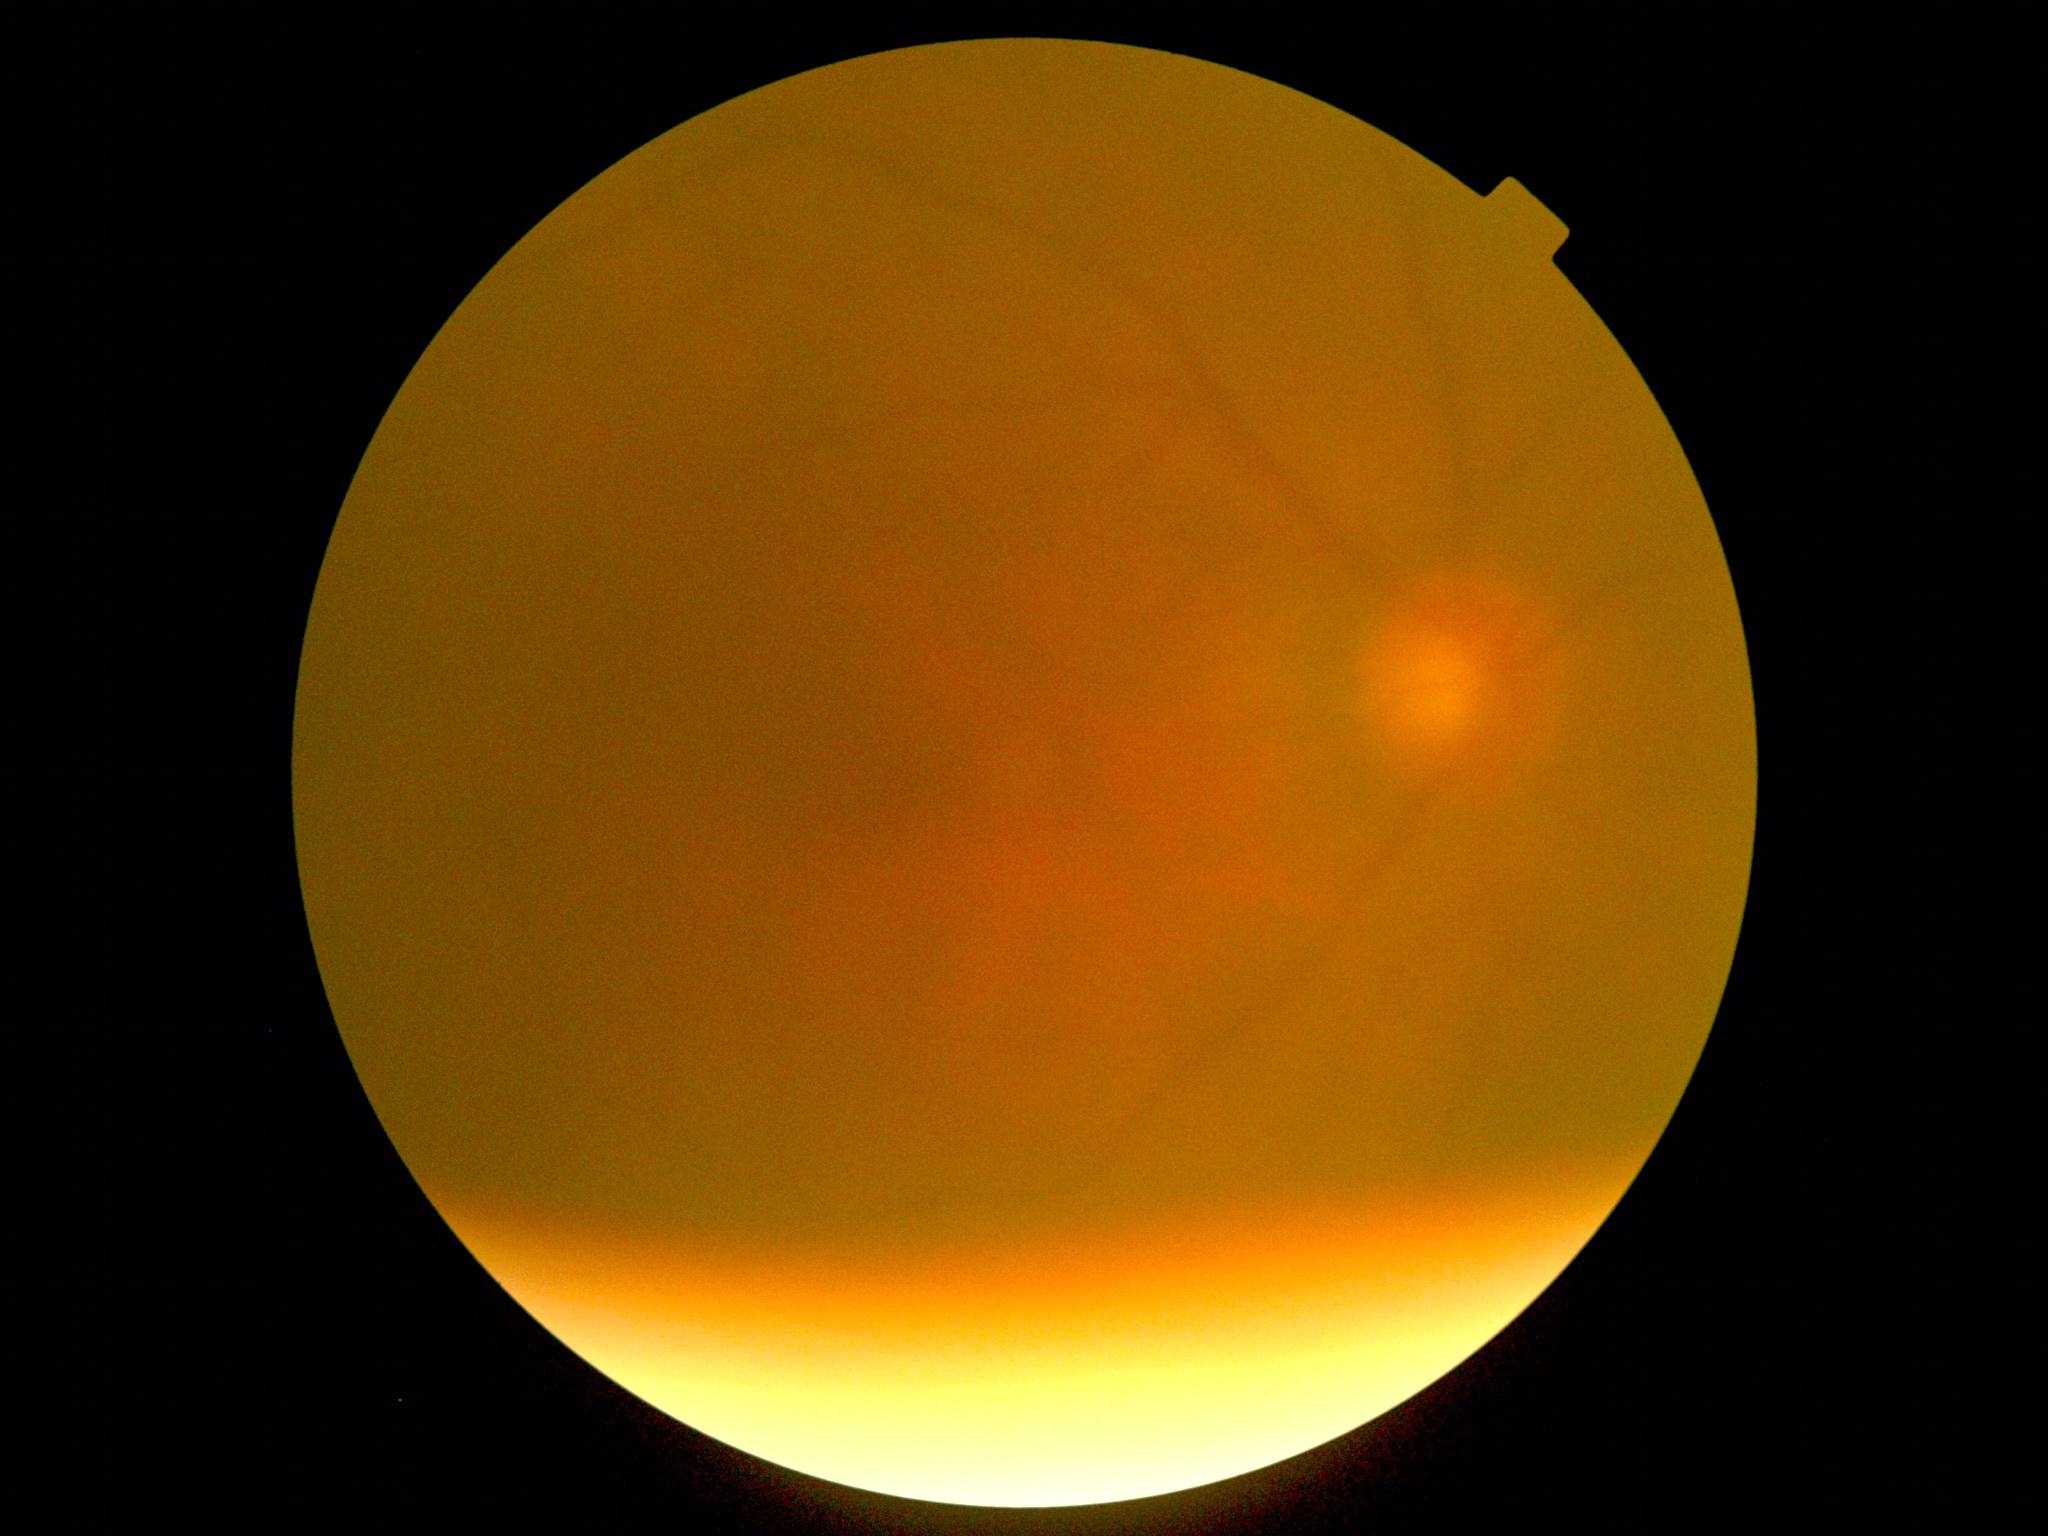

dr_grade: ungradable due to poor image quality
quality: insufficient